No pharmacologic dilation. 45 degree fundus photograph.
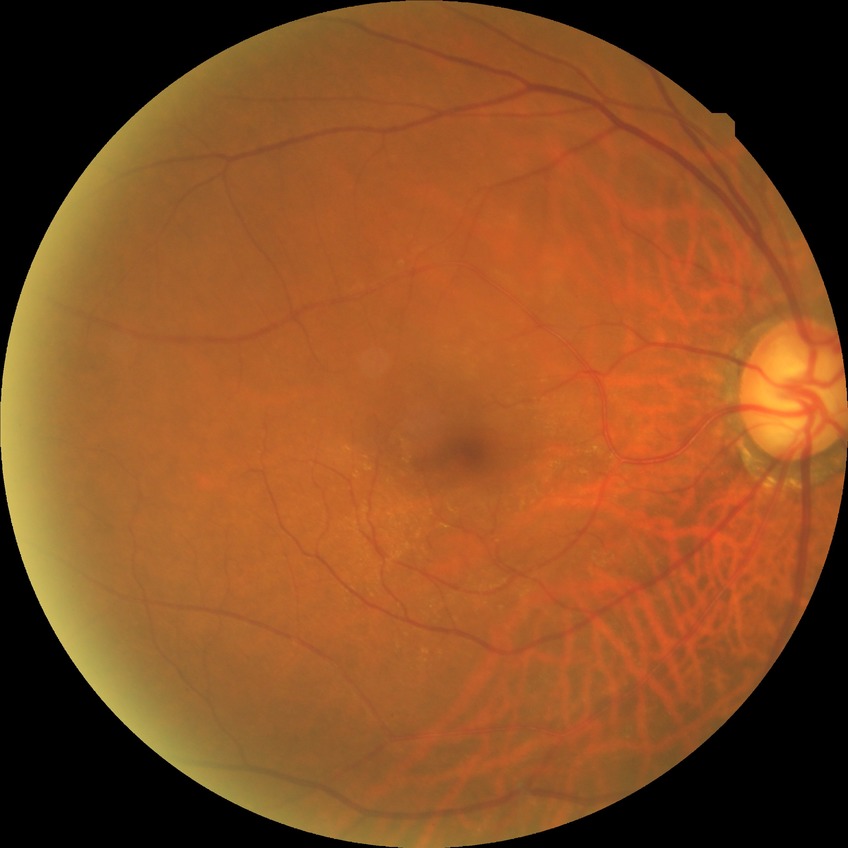 Diabetic retinopathy (DR): no diabetic retinopathy (NDR).